CFP, NIDEK AFC-230 — 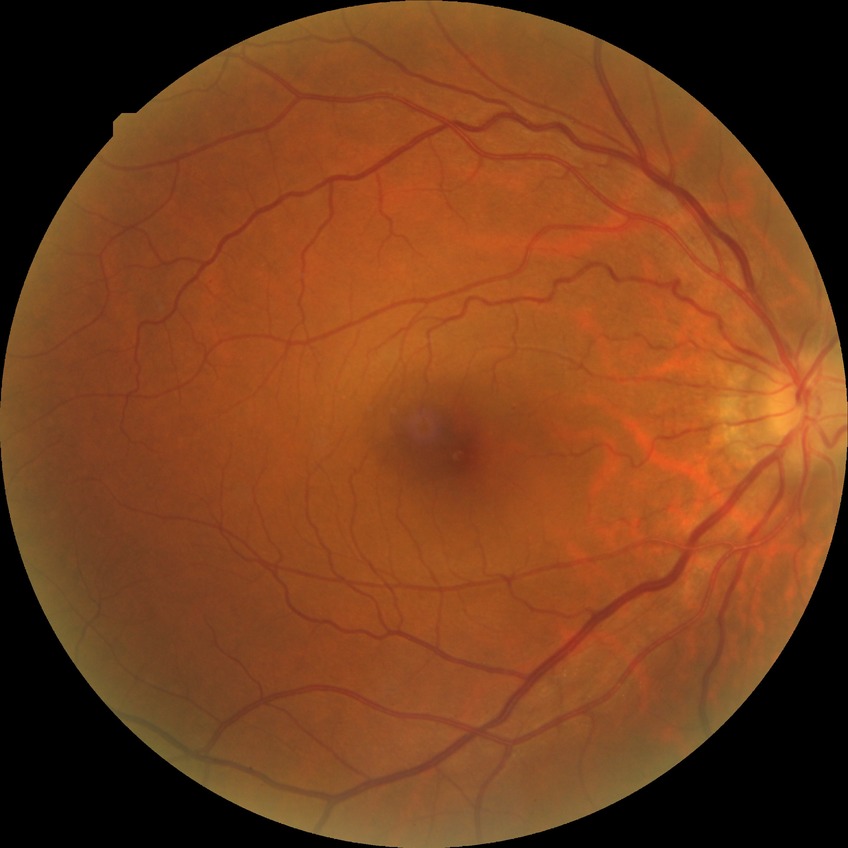

Diabetic retinopathy (DR) is SDR (simple diabetic retinopathy).